Axial length (AL): 22.33 mm · sex: female · corneal thickness: 558 µm · intraocular pressure 14 mmHg (non-contact tonometry)
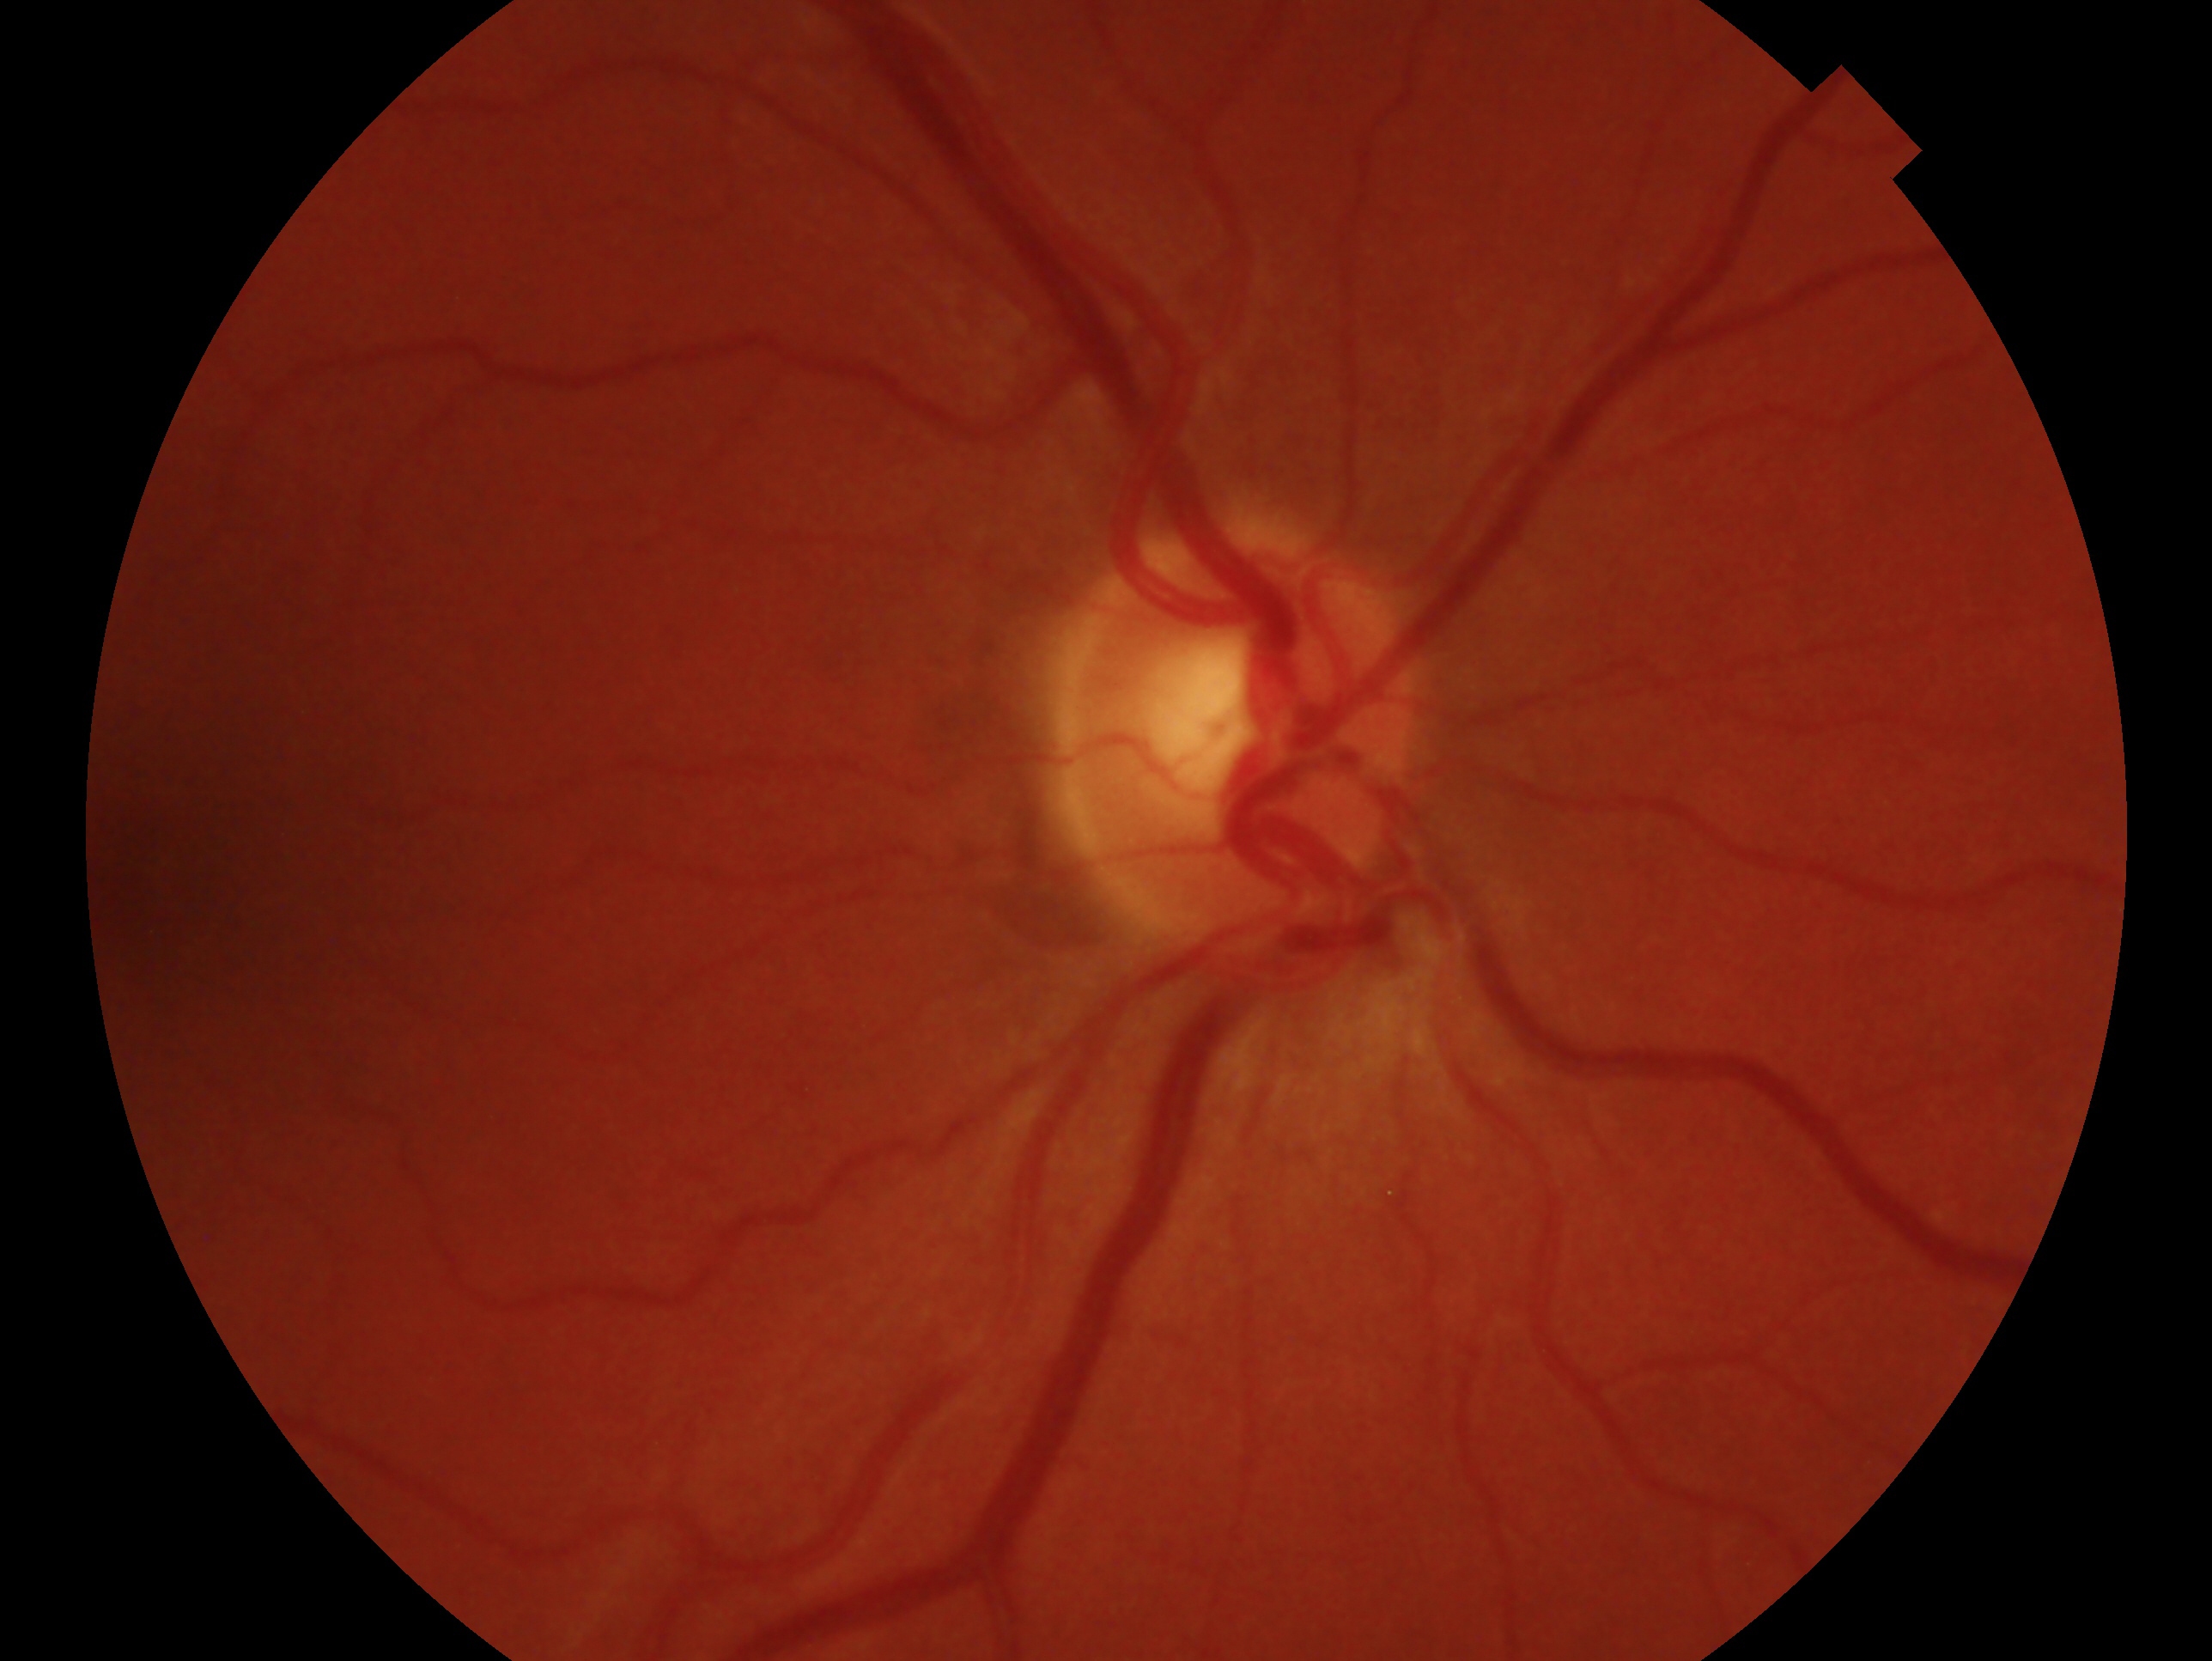 The image shows the oculus dexter. Diagnosis — no glaucoma.